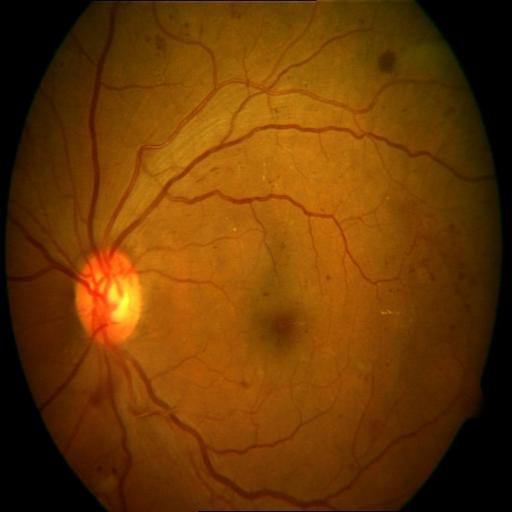 Findings: hemorrhagic retinopathy.